Dilated pupil. Optic disc-centered crop from a color fundus photograph
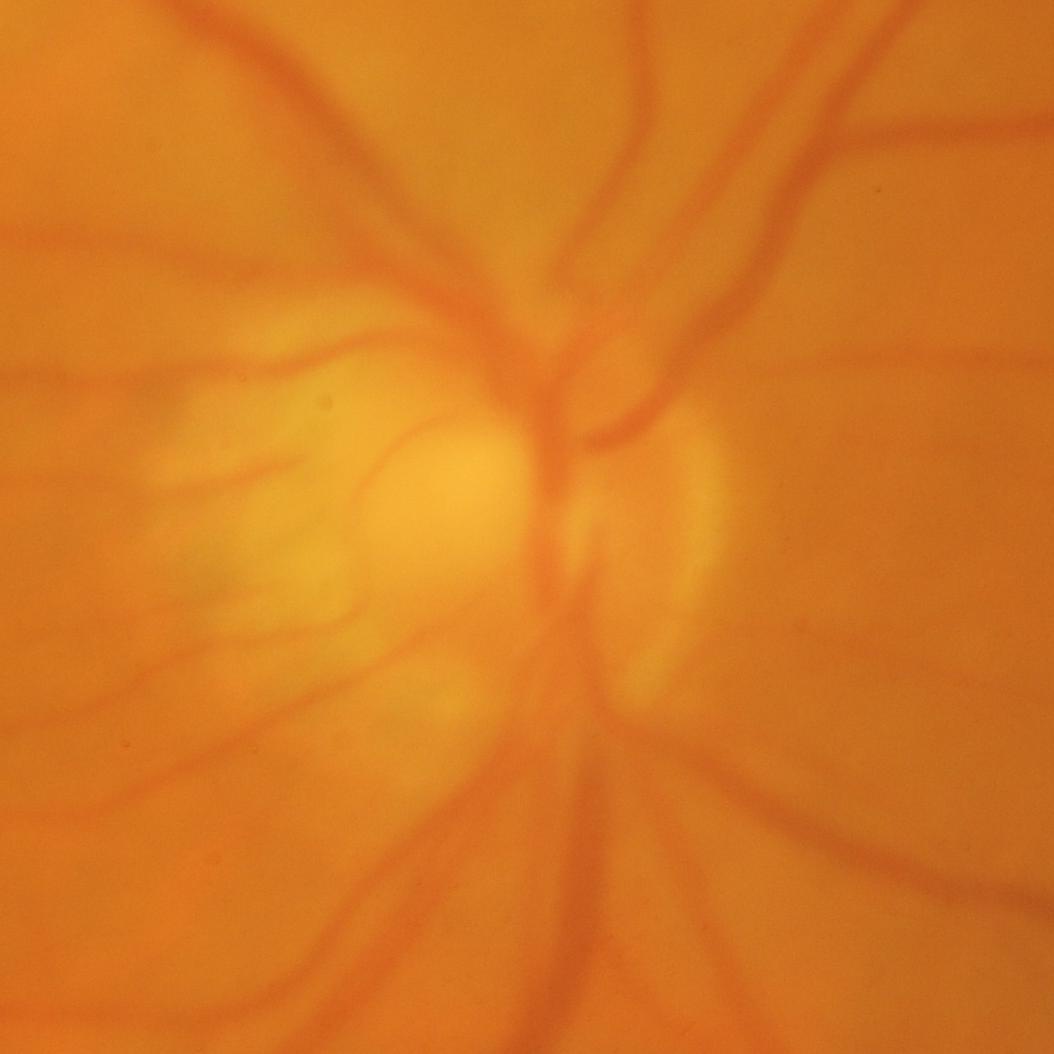 Glaucoma diagnosis: glaucomatous changes.